45° FOV.
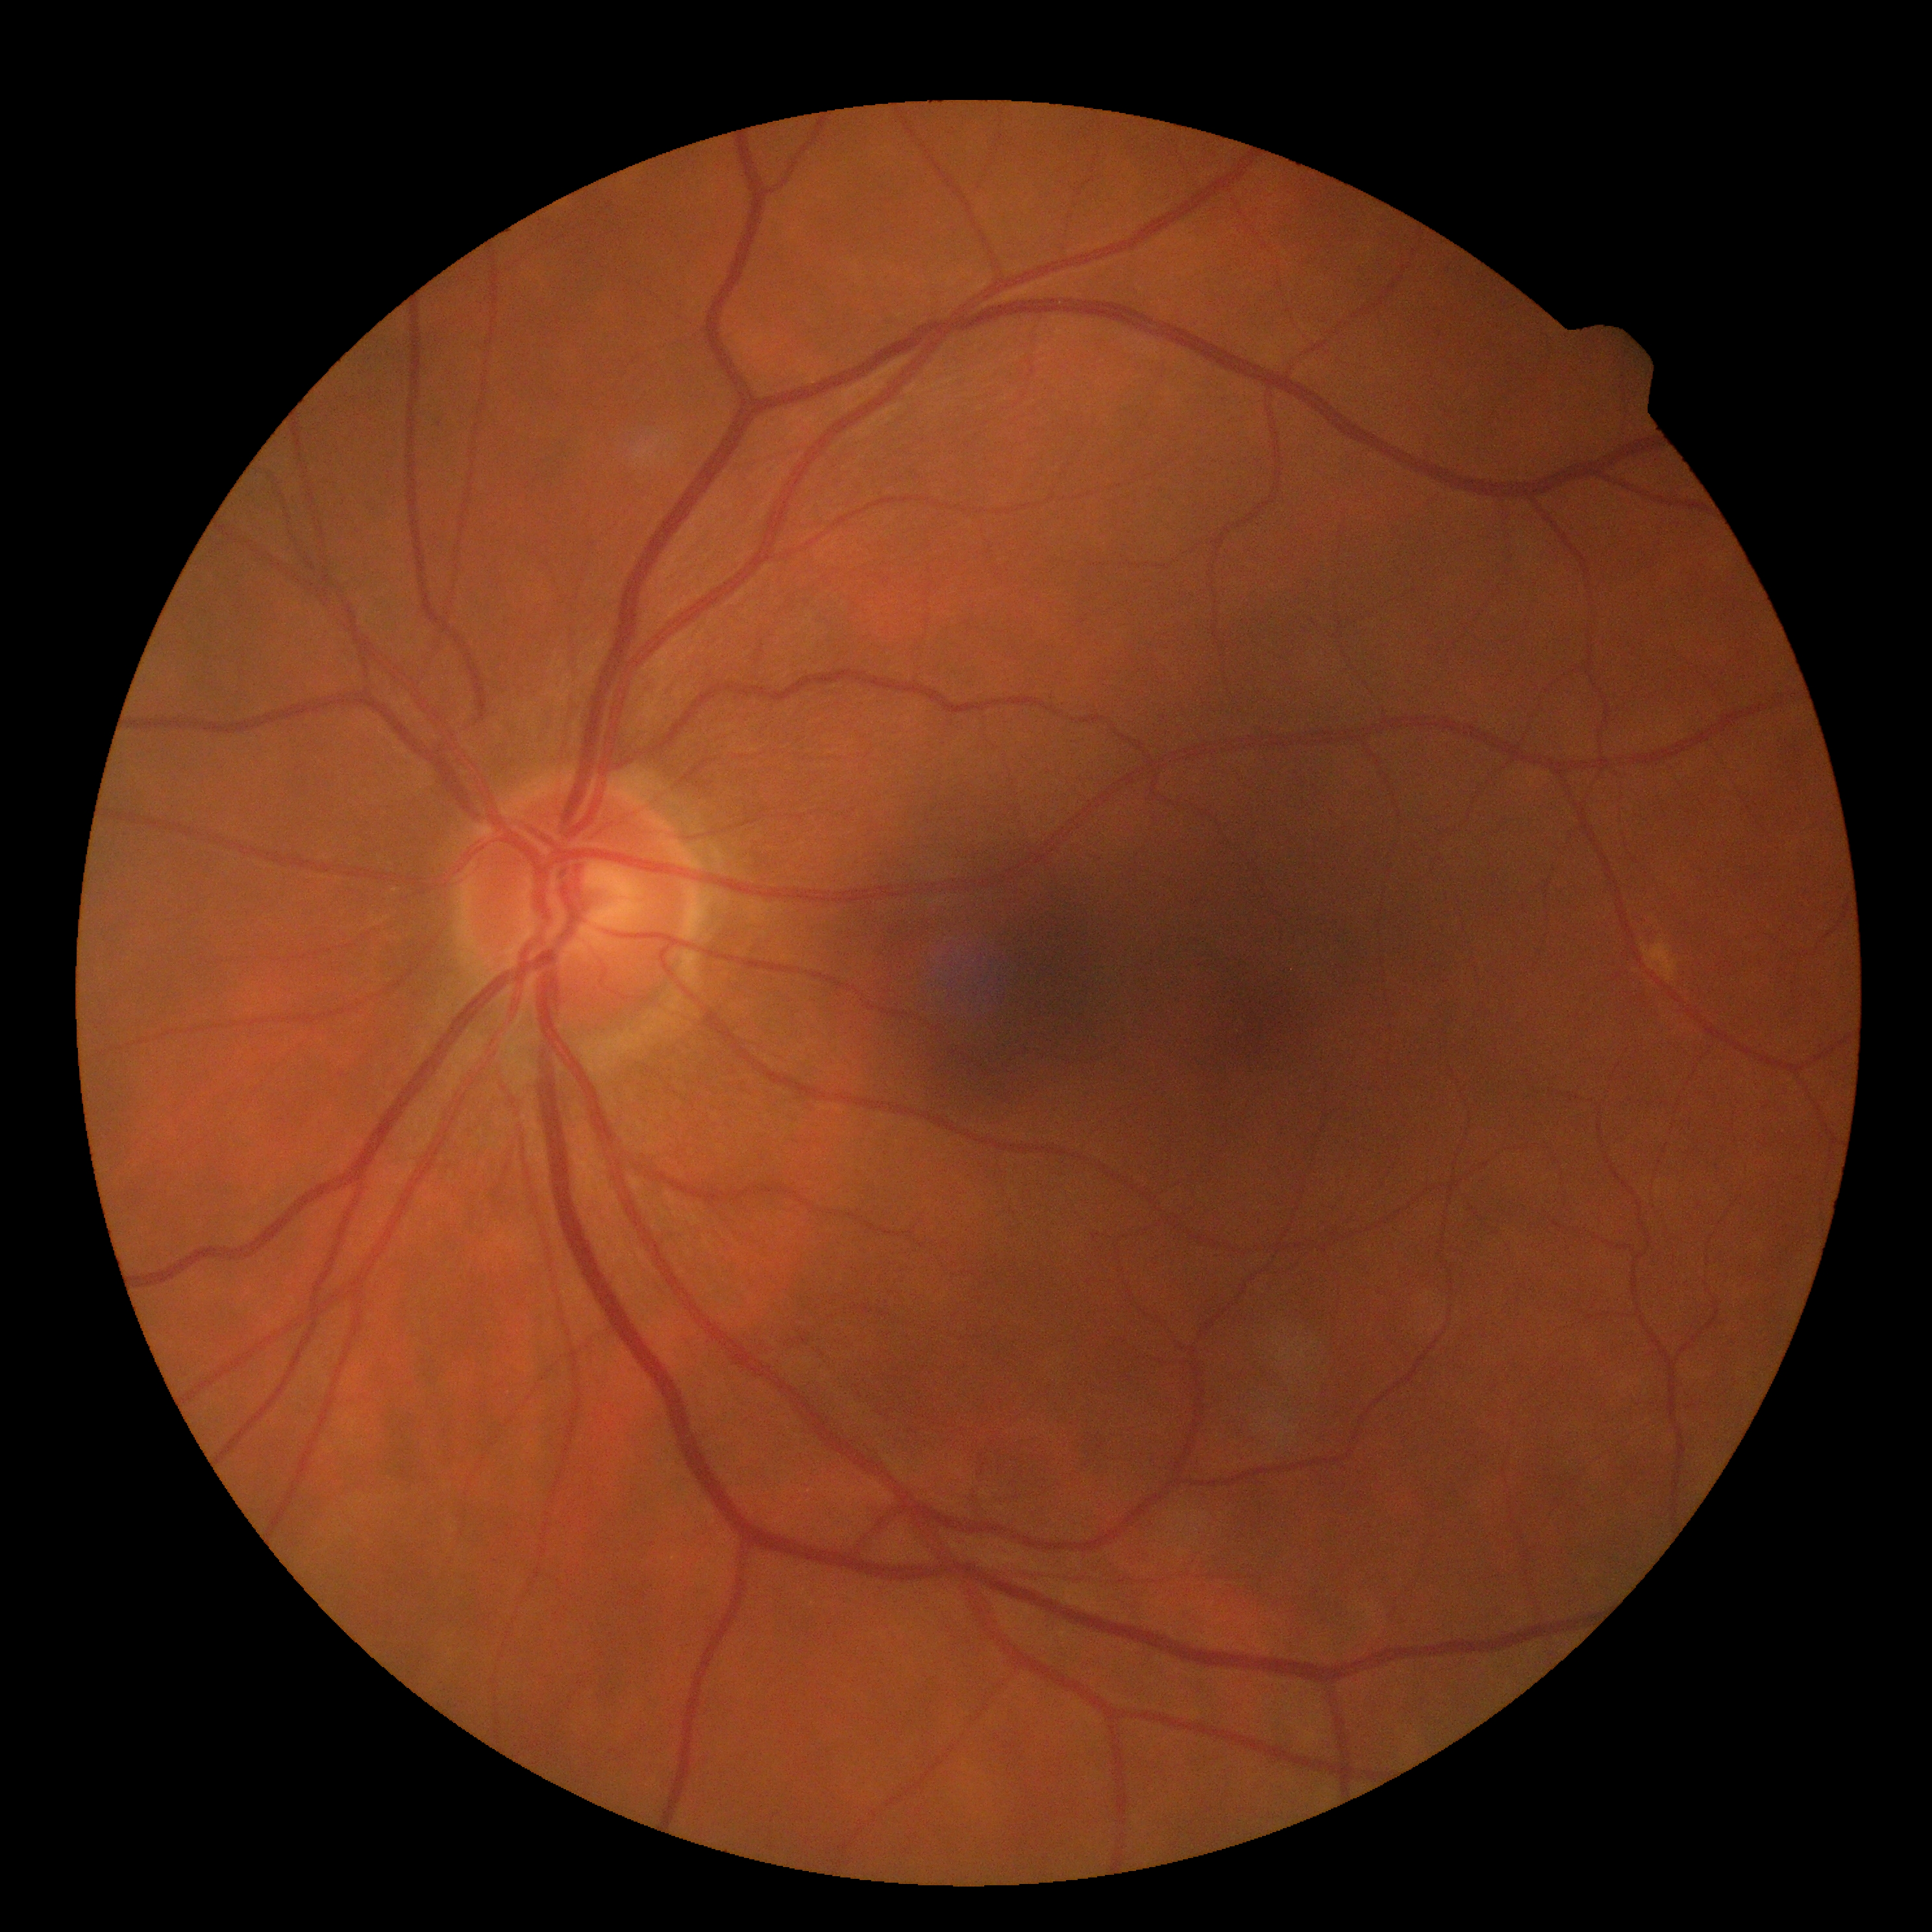 No DR findings. Diabetic retinopathy is grade 0 (no apparent retinopathy) — no visible signs of diabetic retinopathy.